Infant wide-field retinal image; 1440 x 1080 pixels — 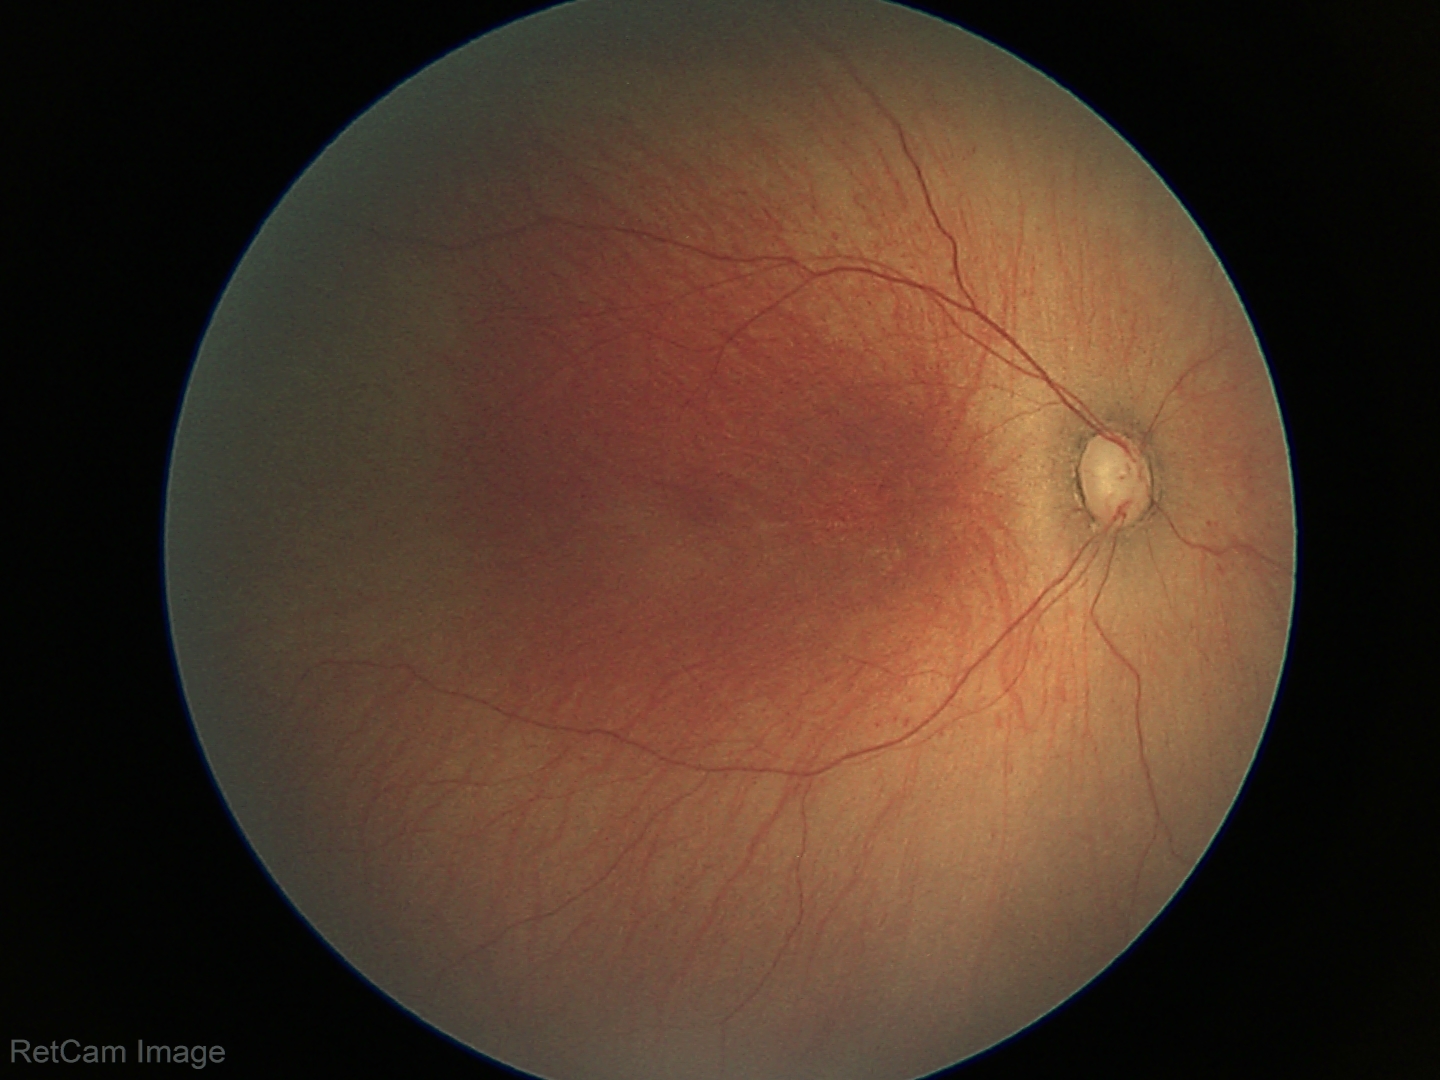 Screening examination consistent with ROP stage 1 — demarcation line between vascular and avascular retina.
Without plus disease.